Centered on the optic disc.
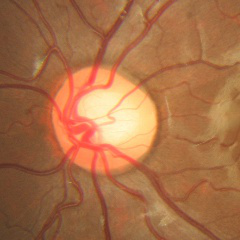
Glaucoma stage = no glaucomatous changes.